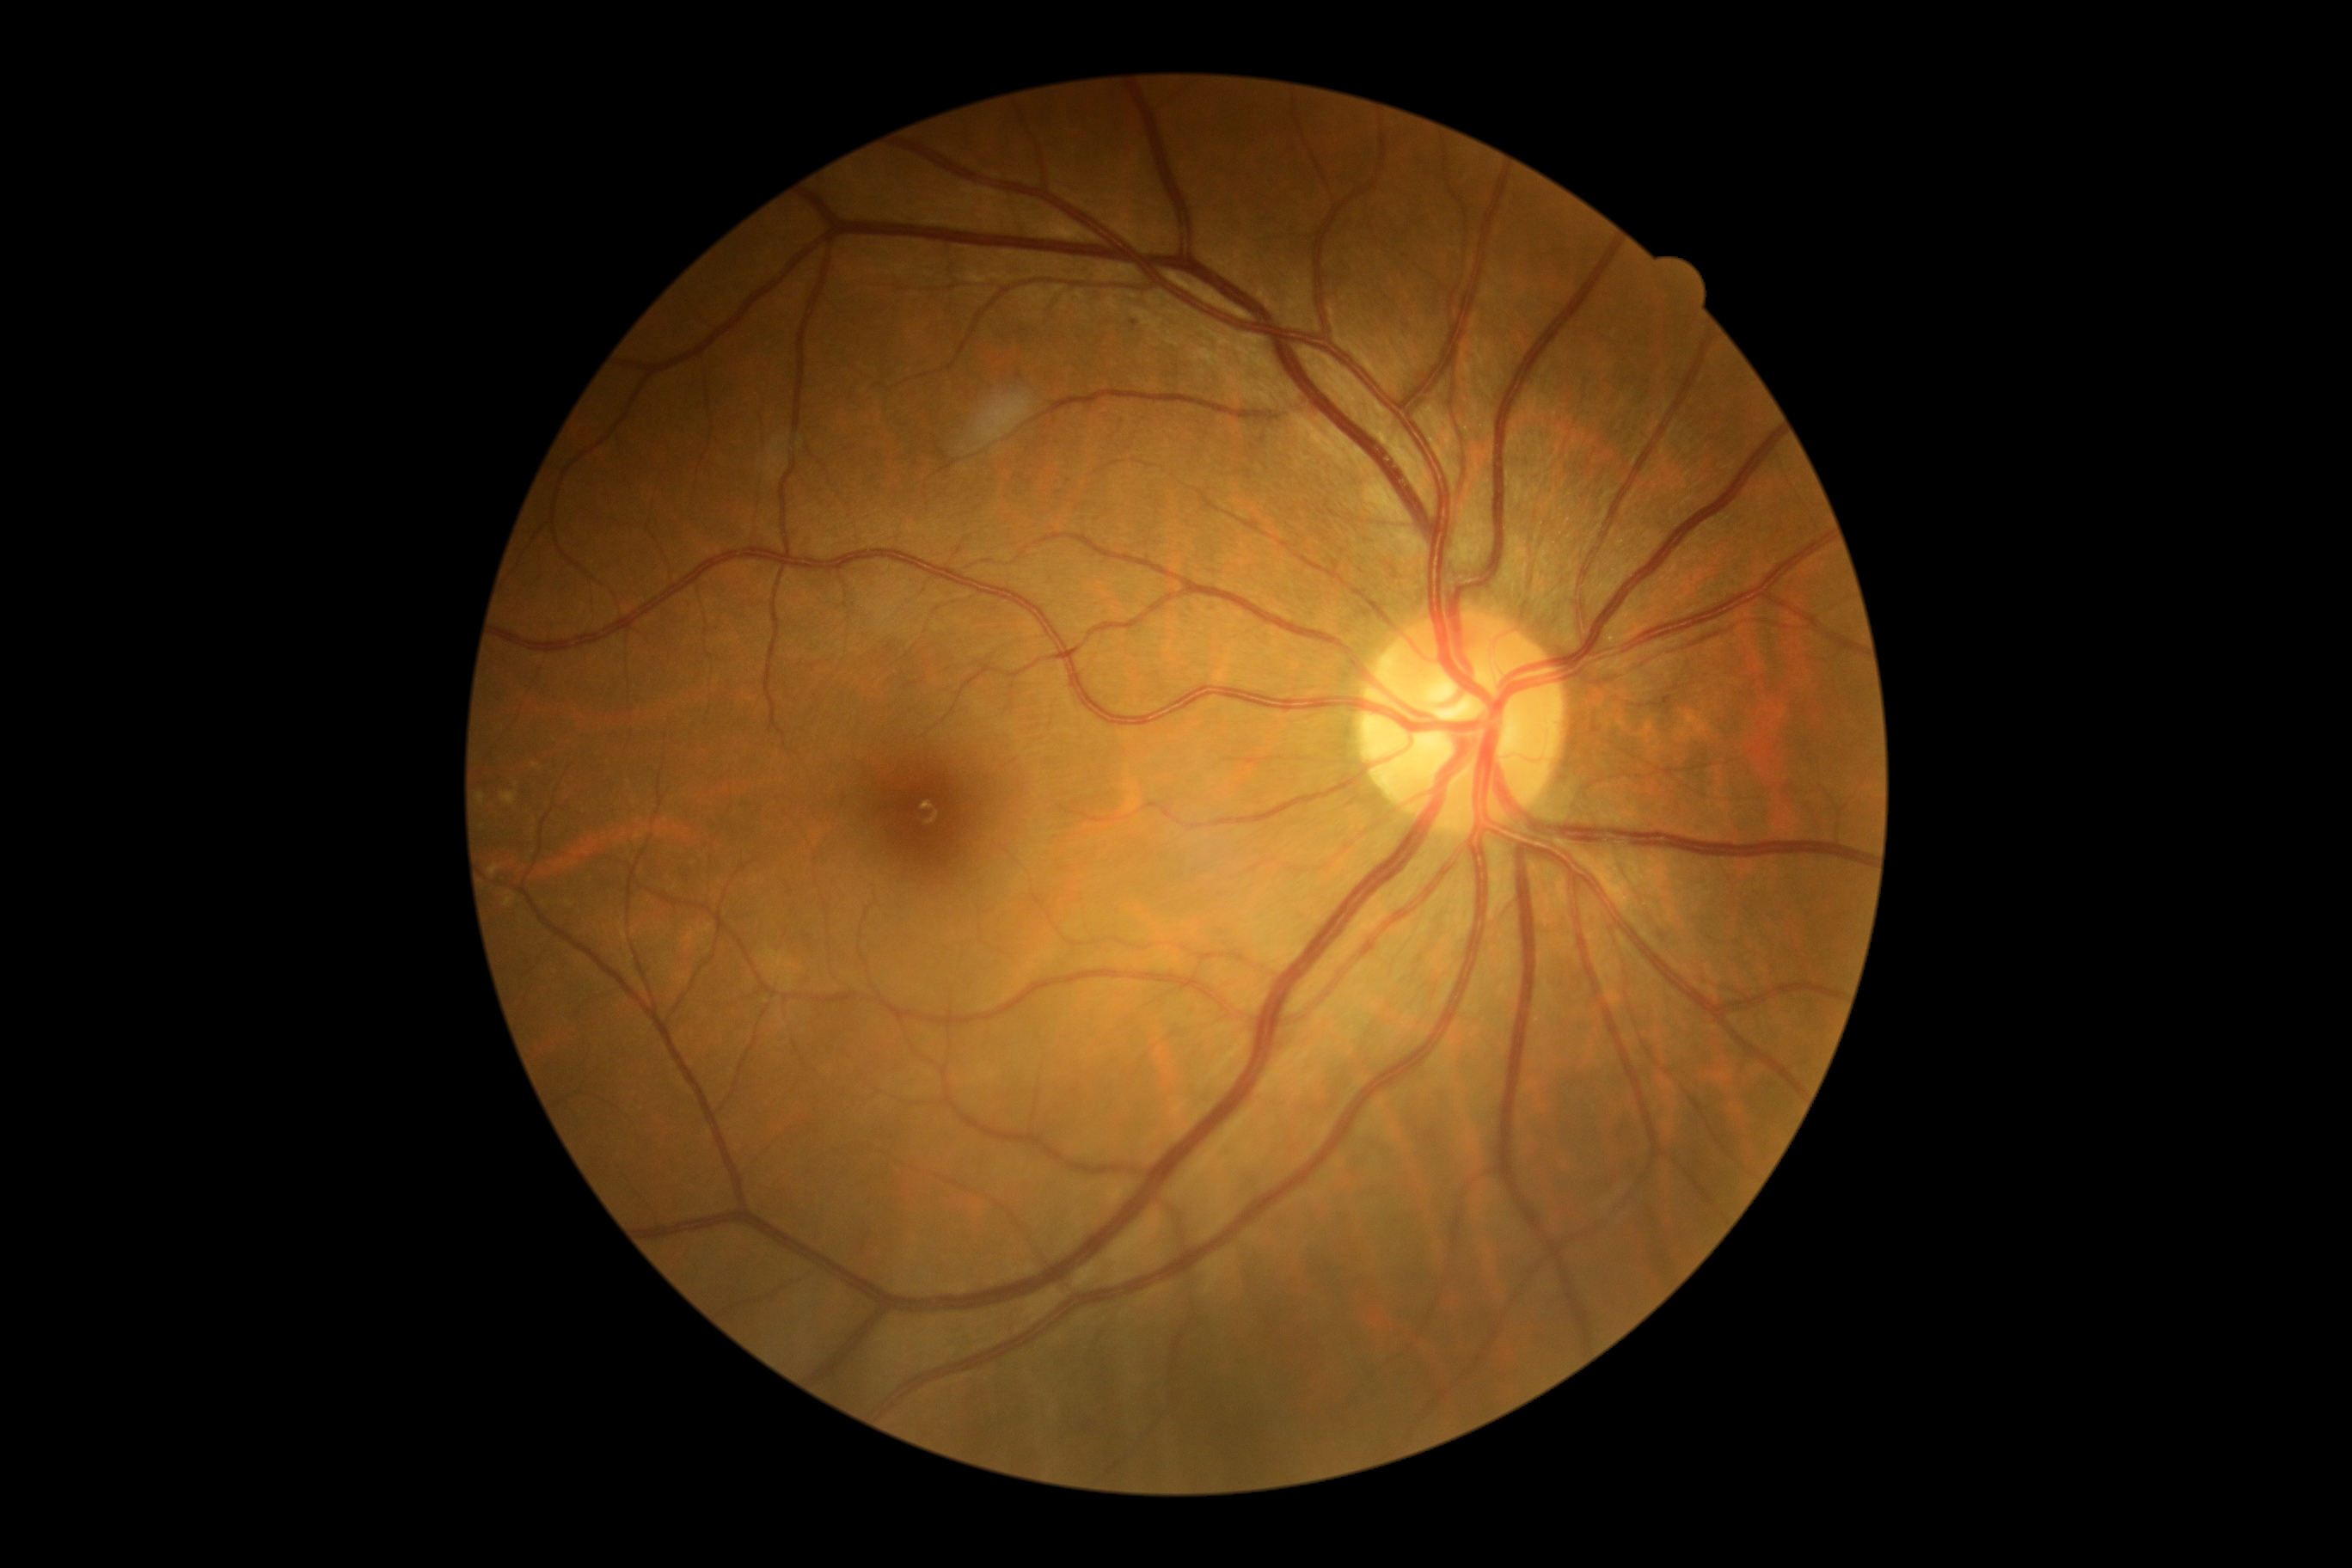
Retinopathy: grade 1 (mild NPDR).